NIDEK AFC-230. 848 x 848 pixels. Retinal fundus photograph:
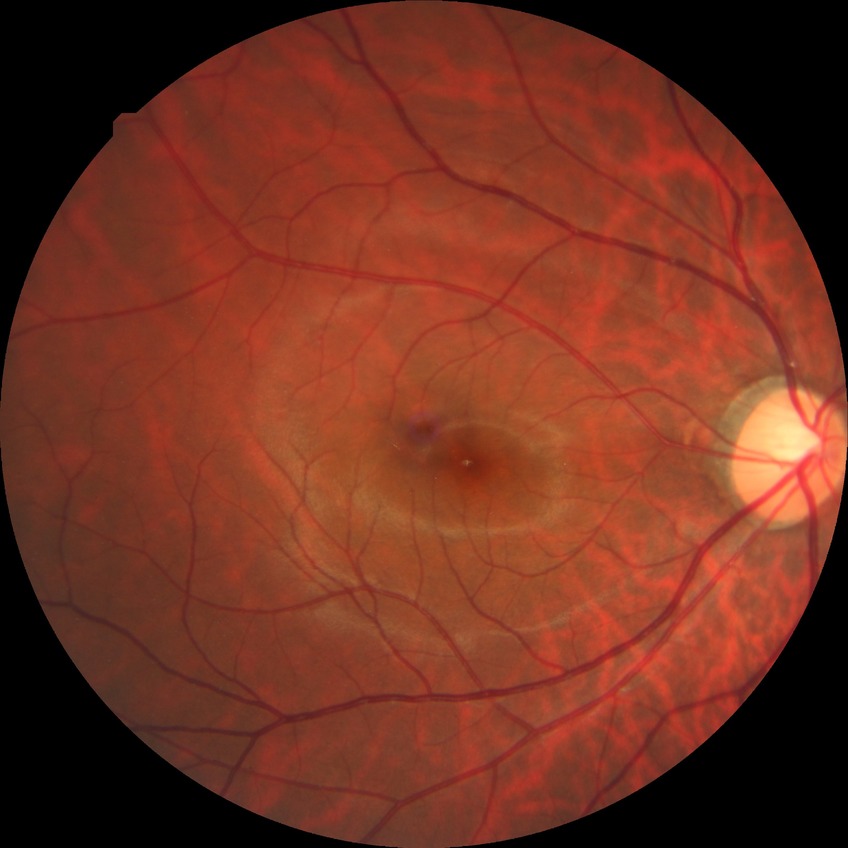 No diabetic retinal disease findings. Davis DR grade: NDR.